Color fundus image: 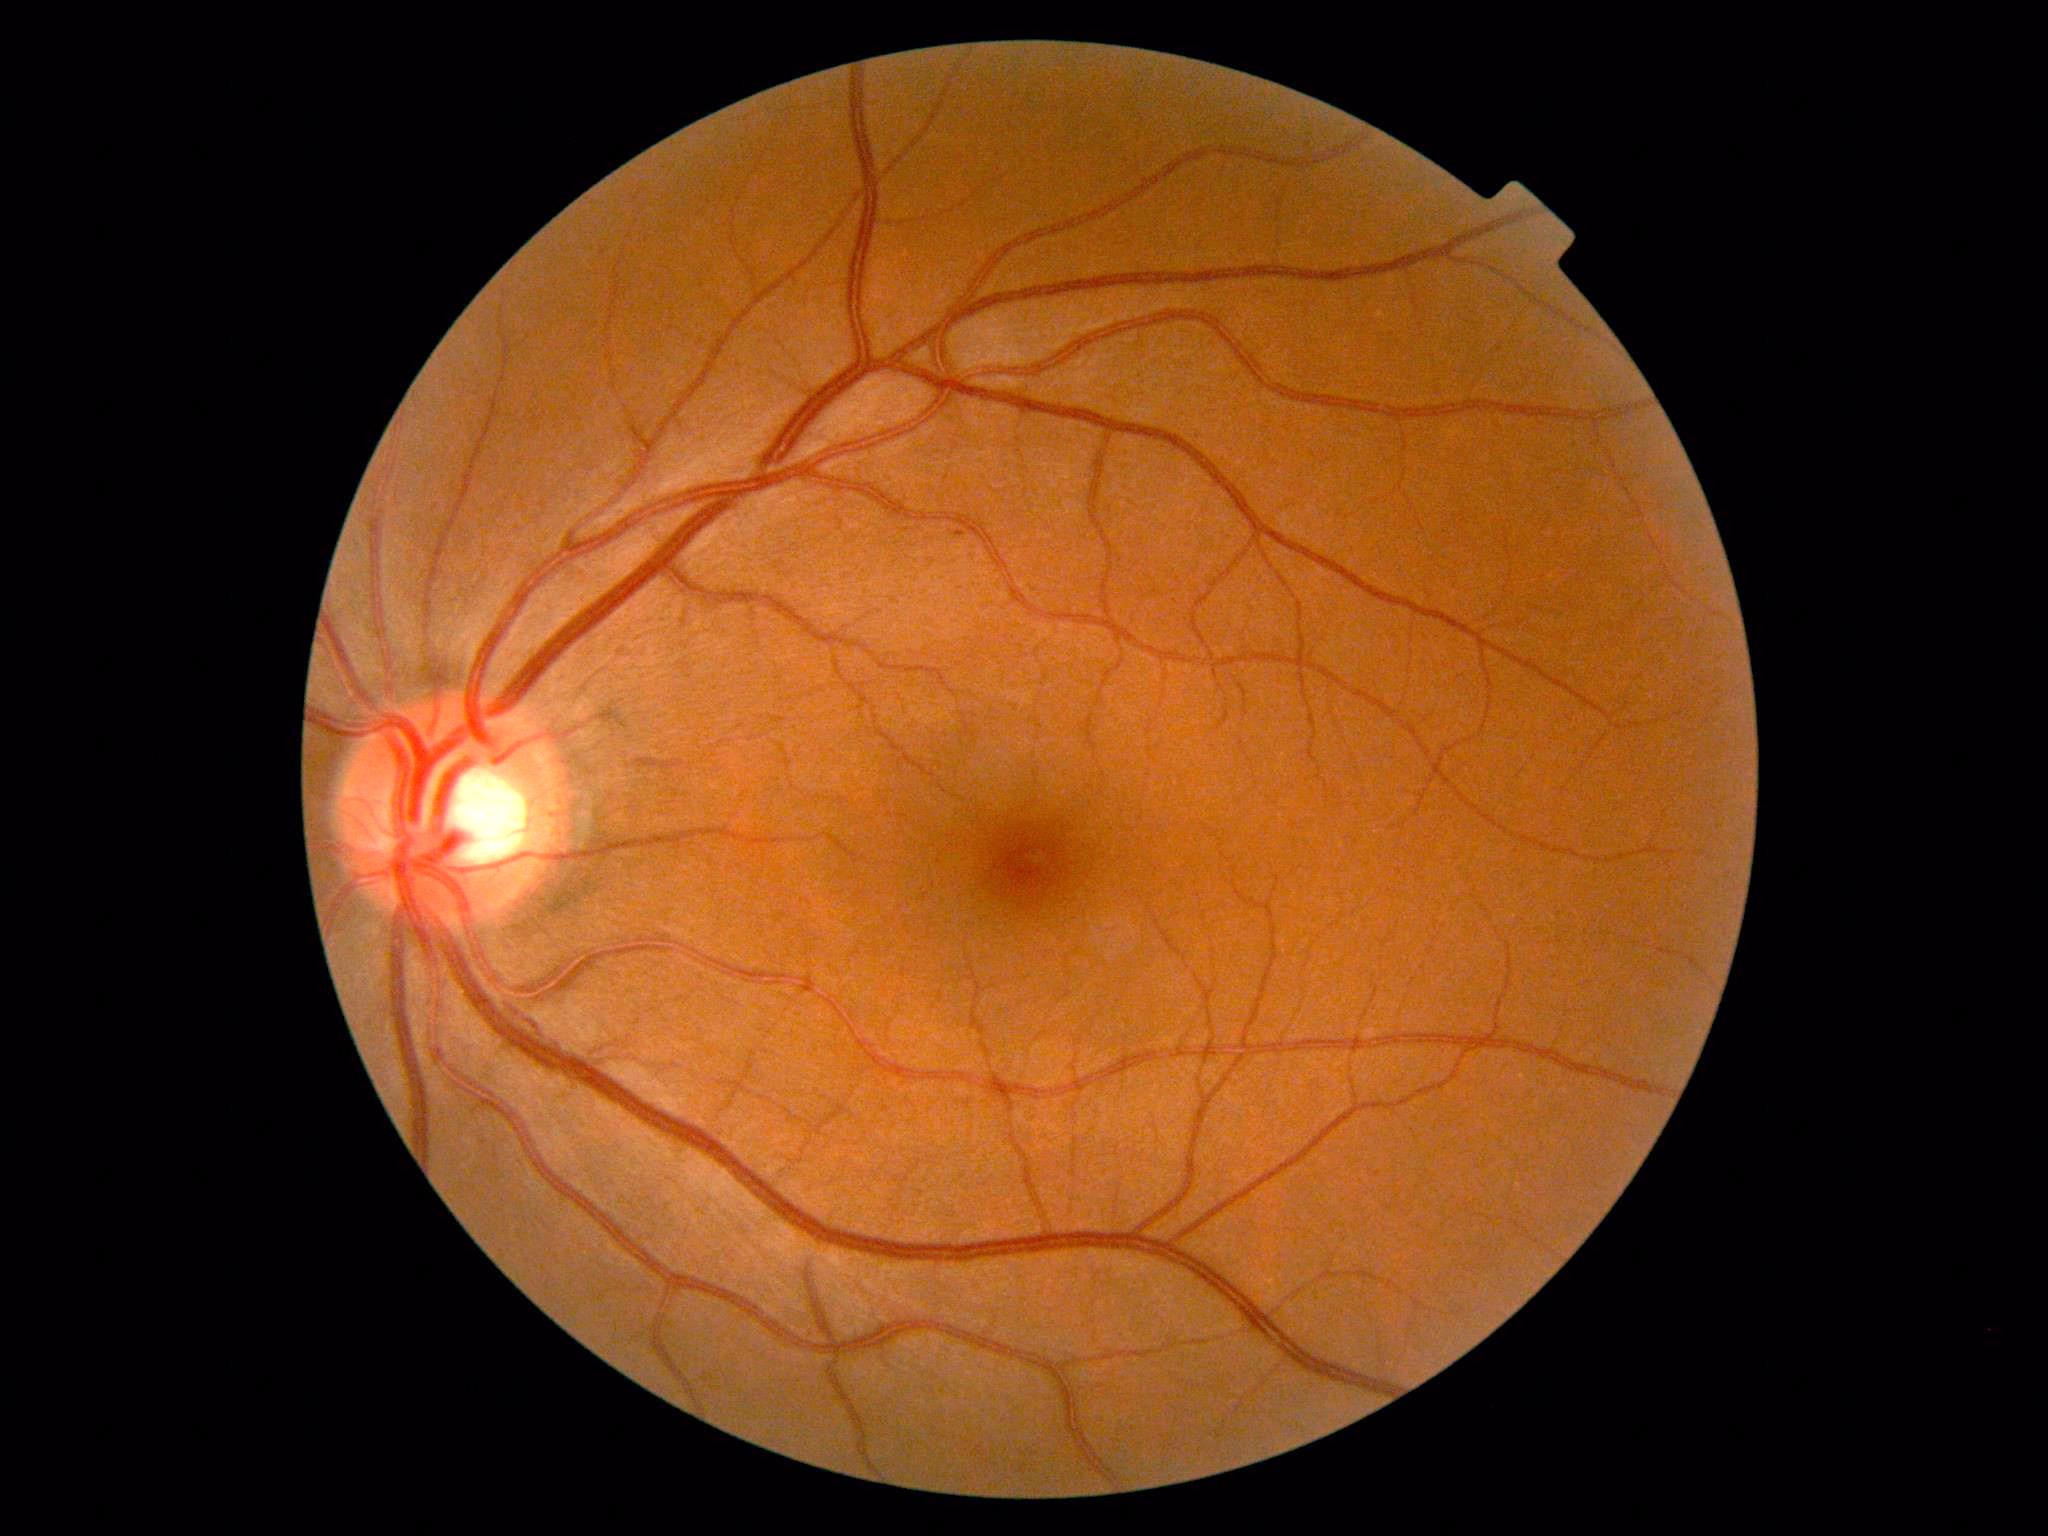

DR=grade 1 (mild NPDR).